CFP; 2184x1682:
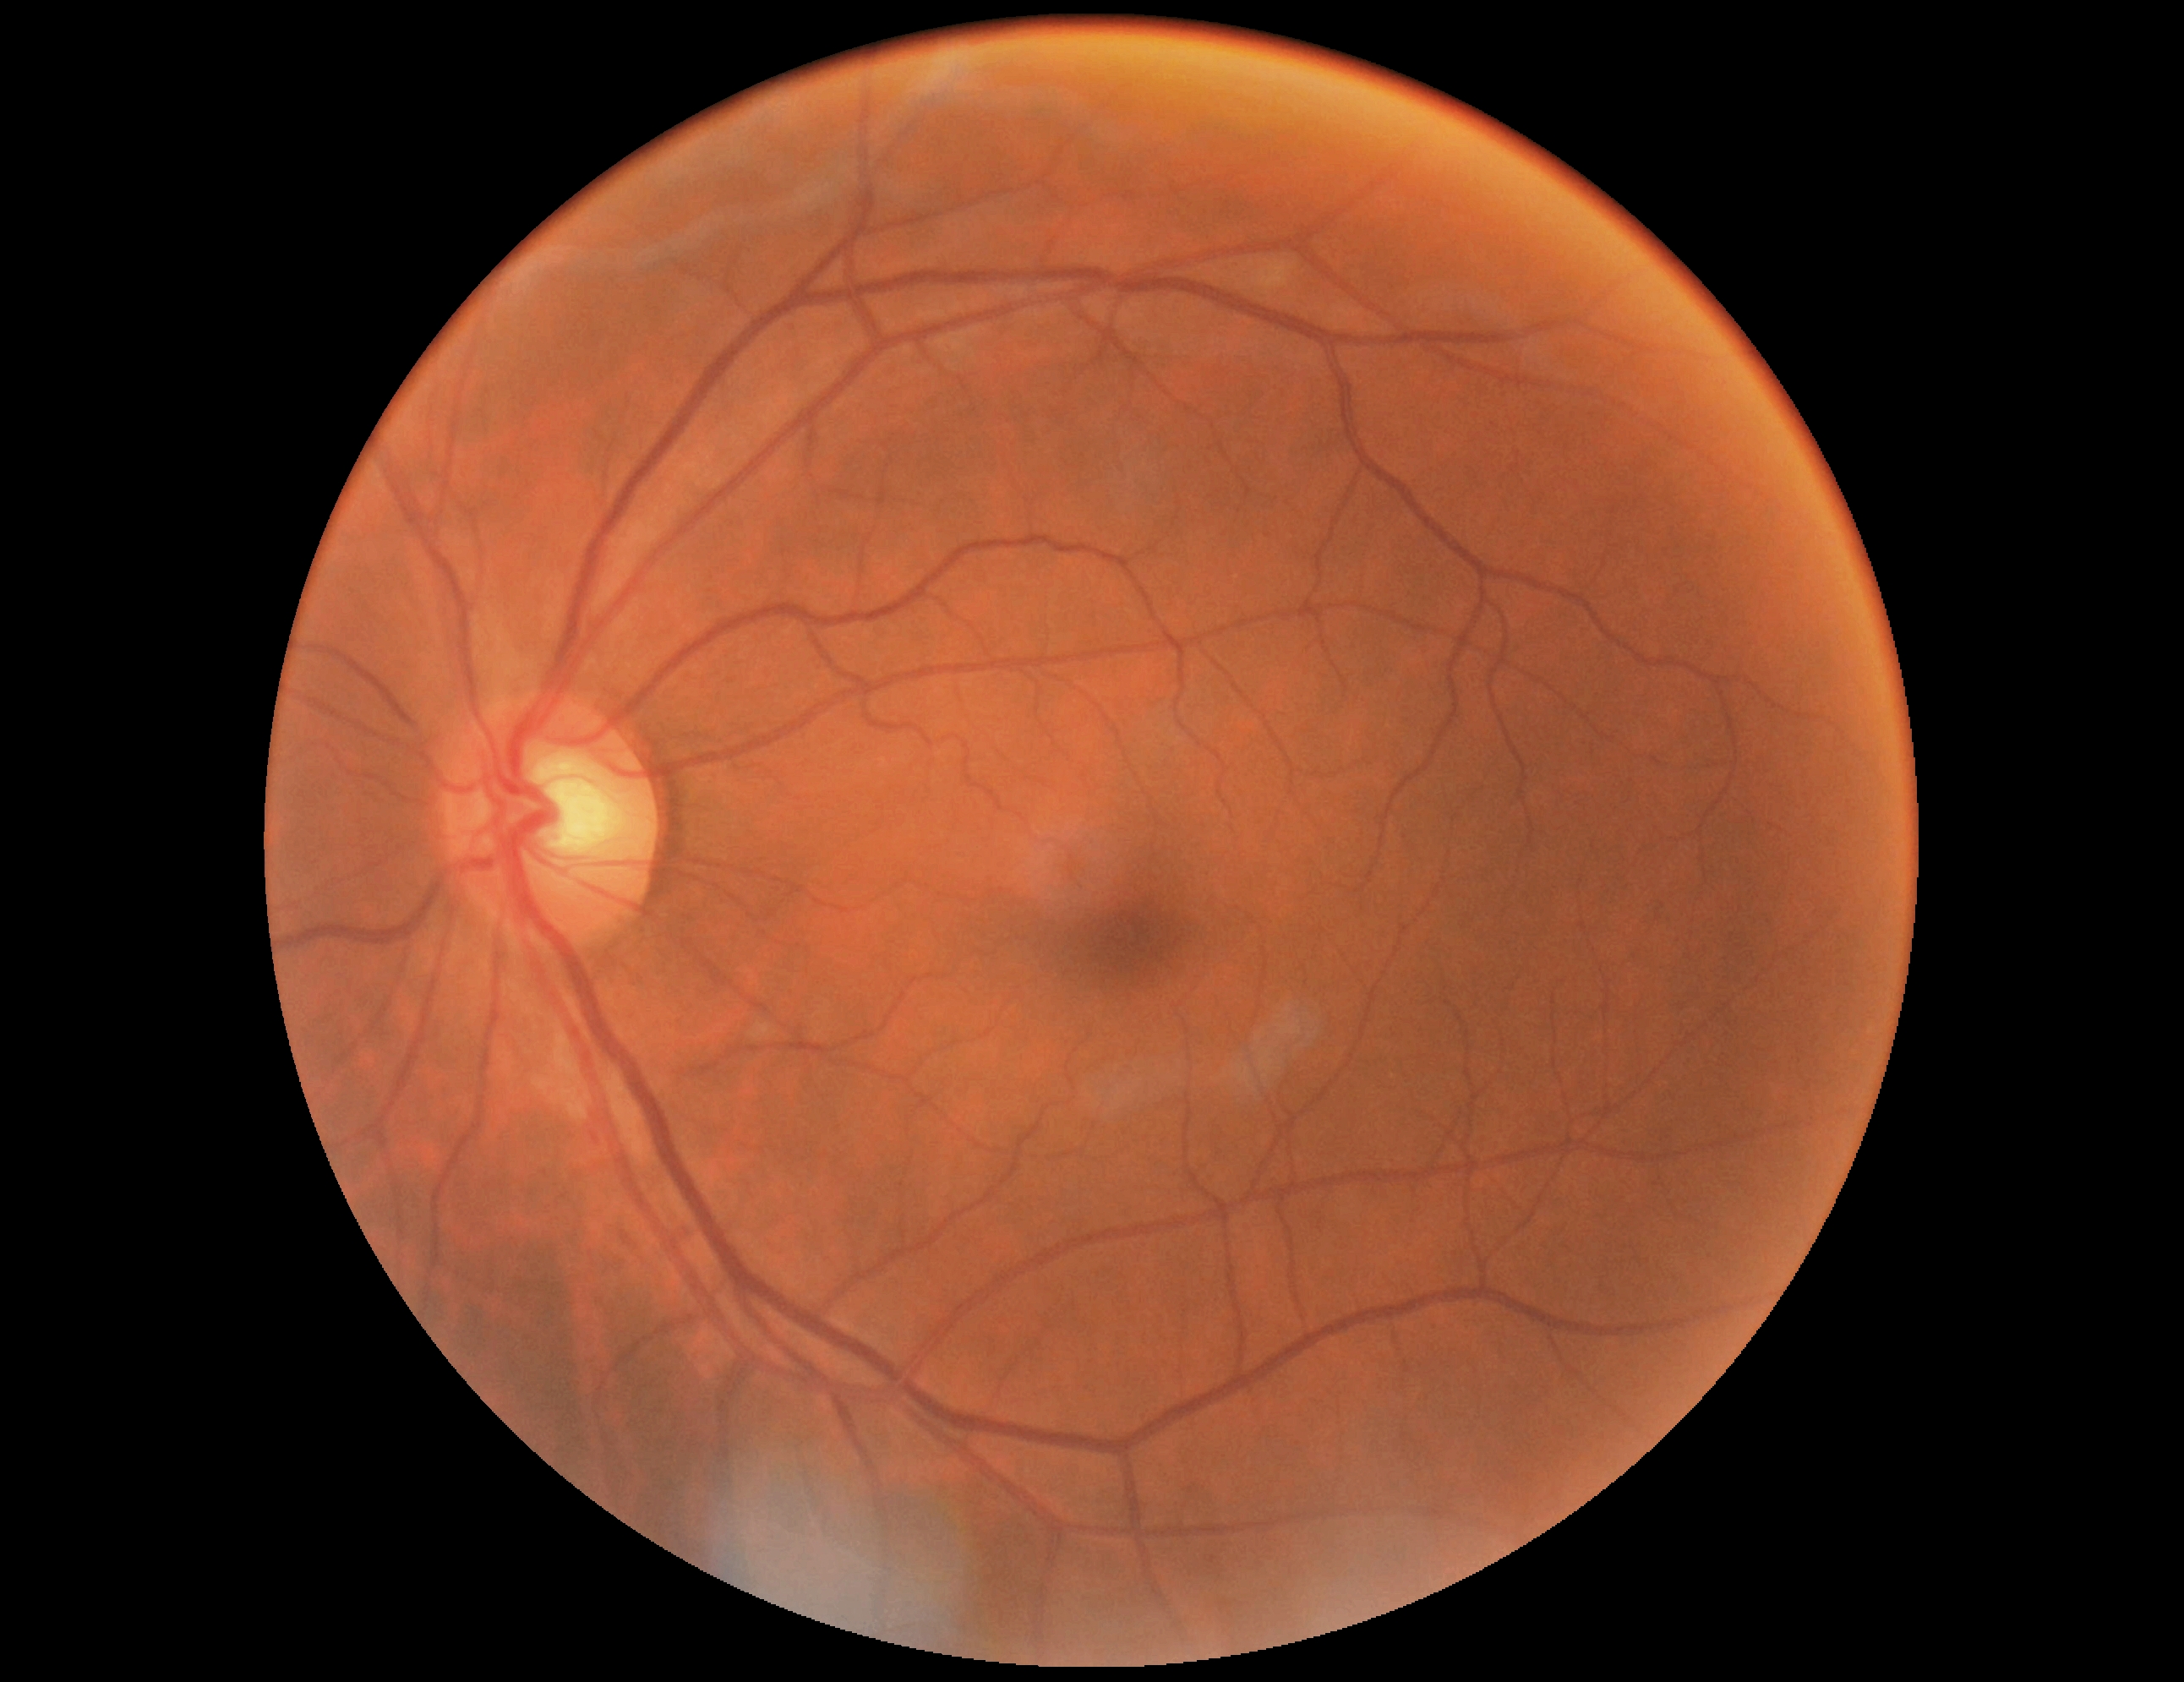
Diabetic retinopathy: 0/4.